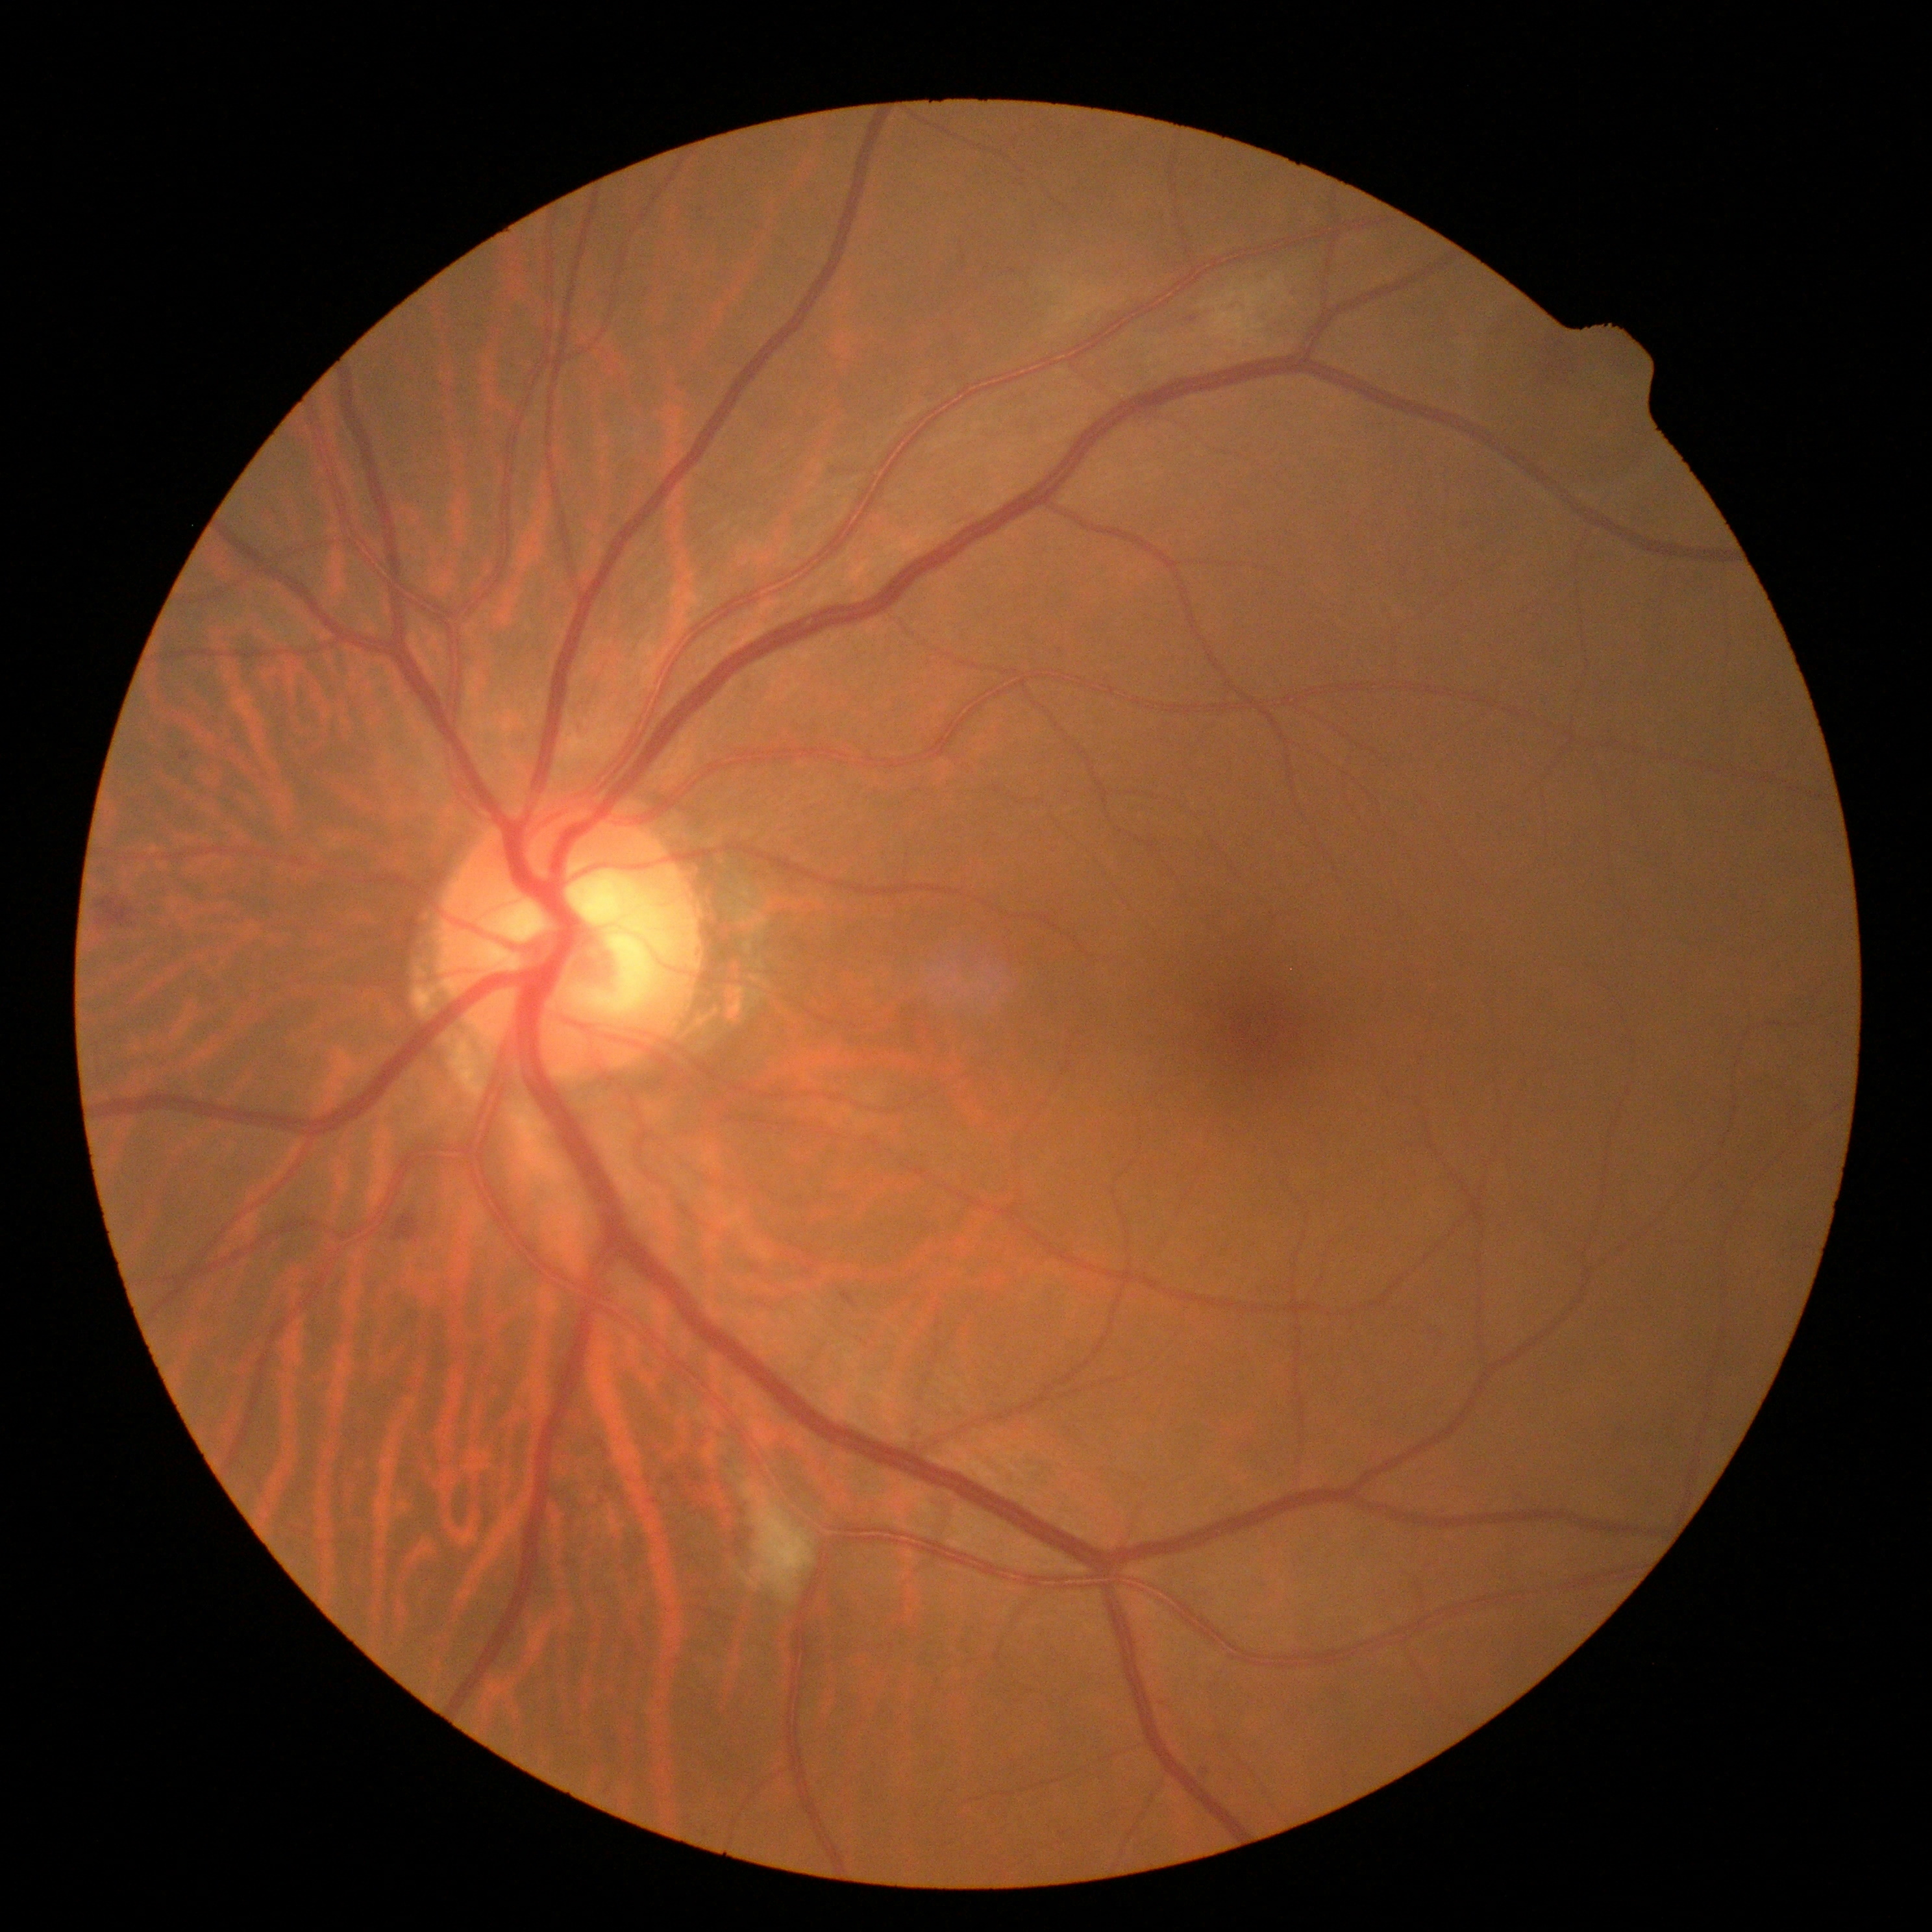 DR grade: 2.